Image size 848x848; camera: NIDEK AFC-230; graded on the modified Davis scale — 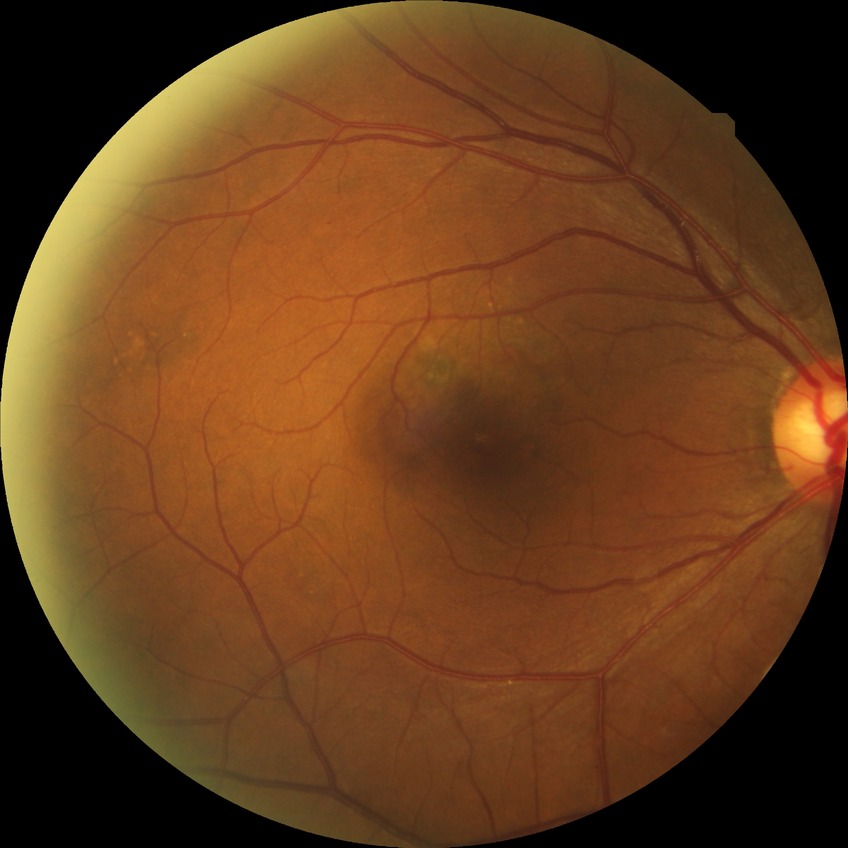
Findings:
* diabetic retinopathy grade: no diabetic retinopathy